Ultra-widefield fundus photograph.
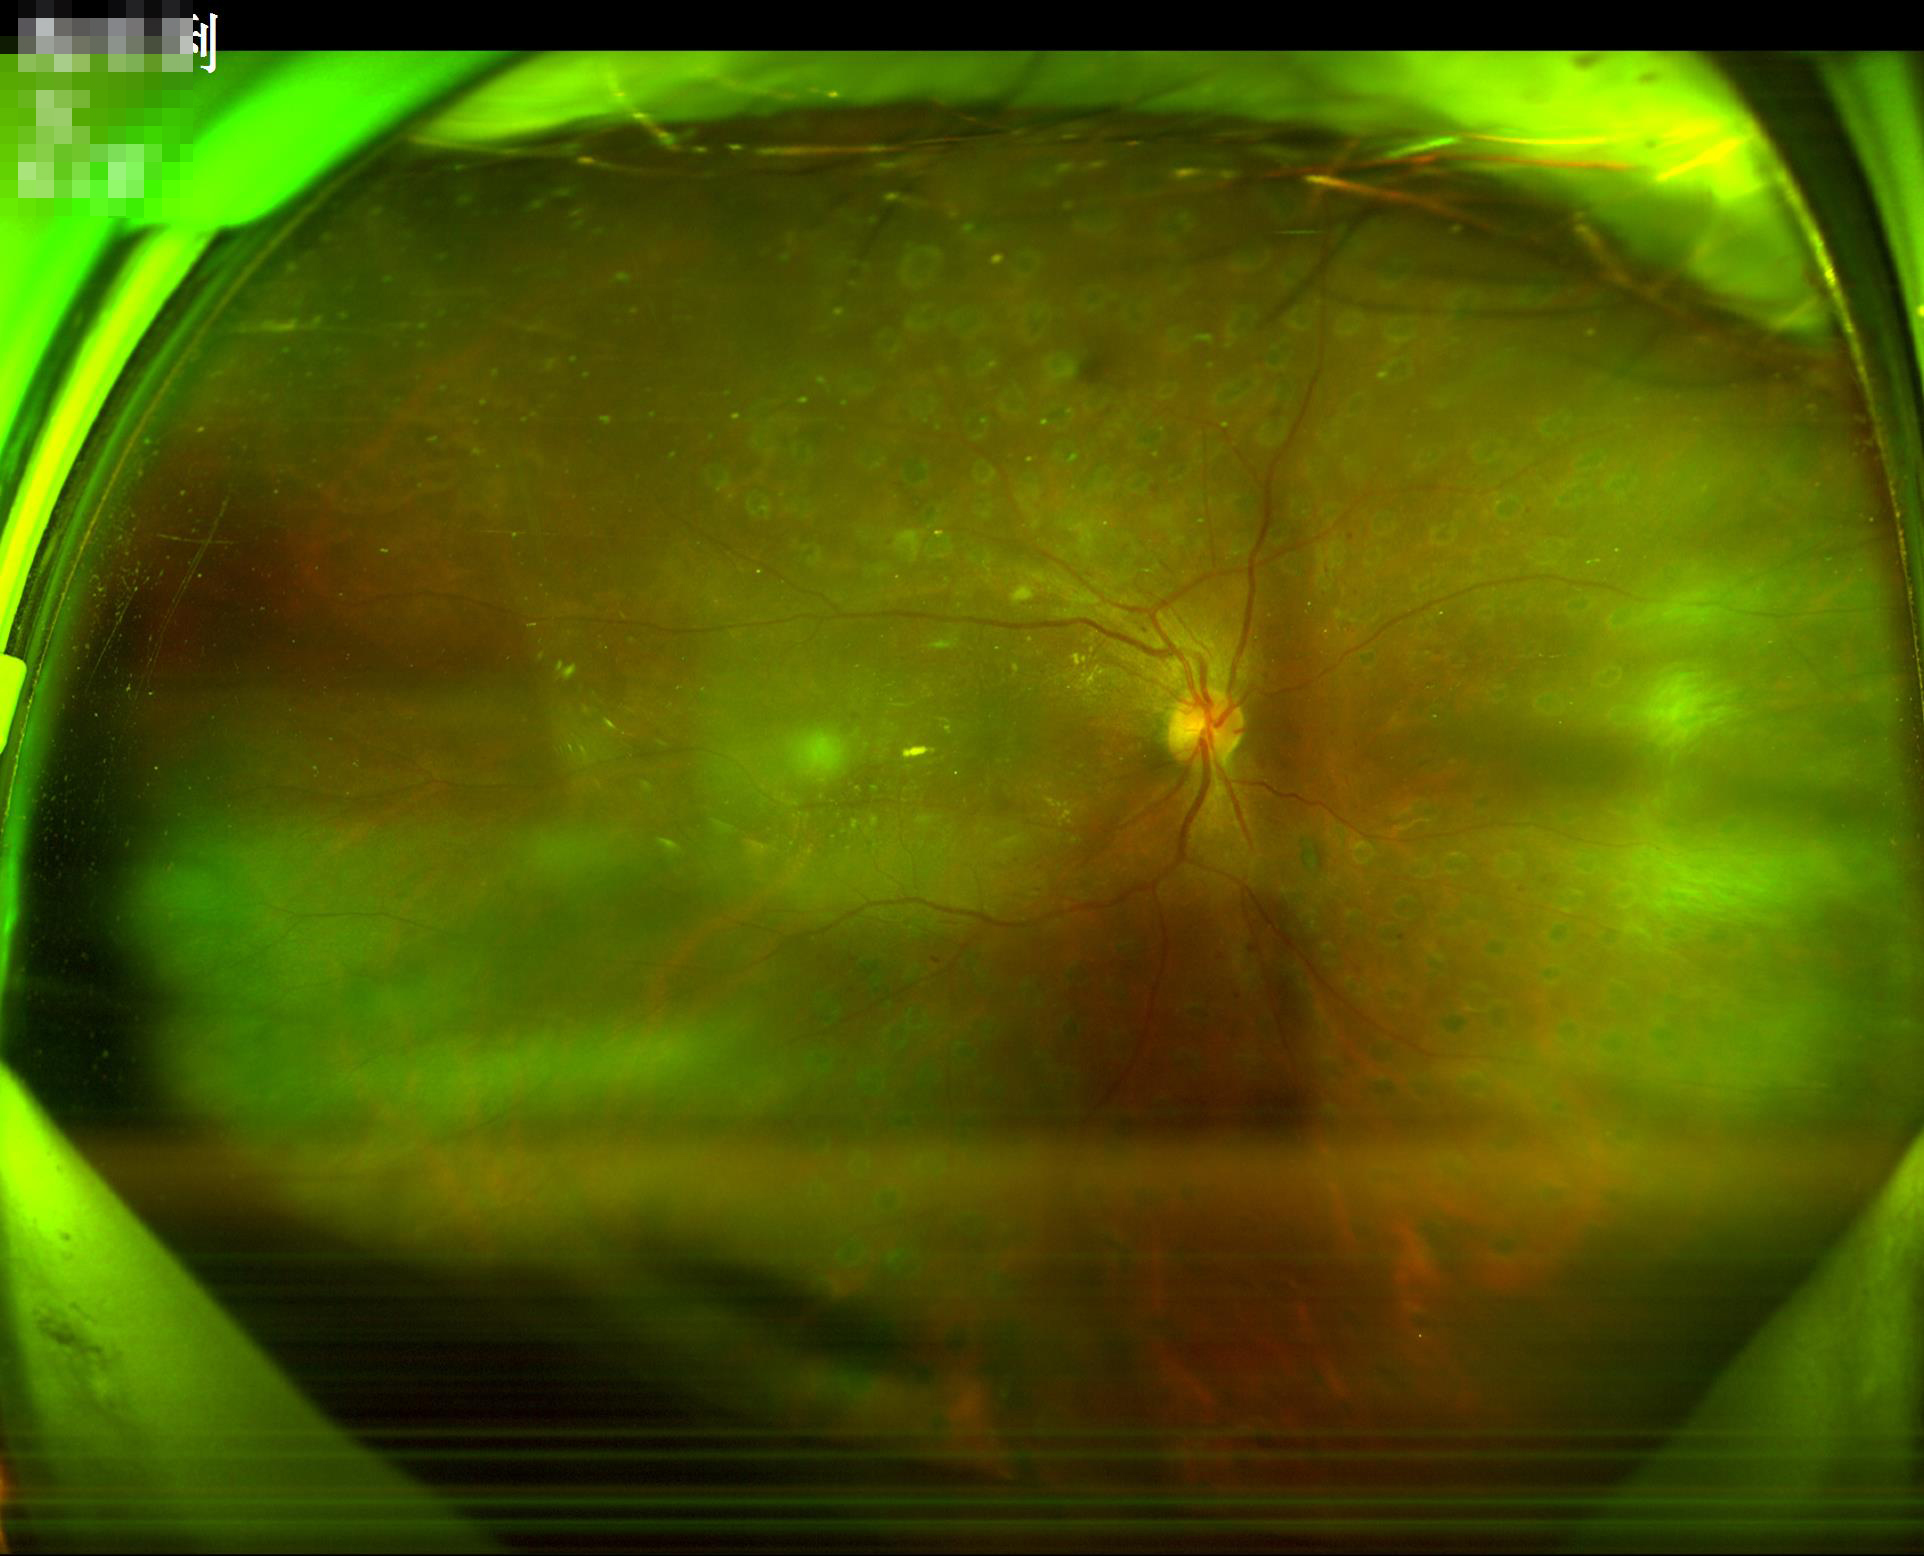 Contrast: good dynamic range | Overall quality: poor, ungradable | Focus: noticeable blur in the optic disc, vessels, or background | Illumination/color: uniform, no color cast.